Mydriatic (tropicamide and phenylephrine) — 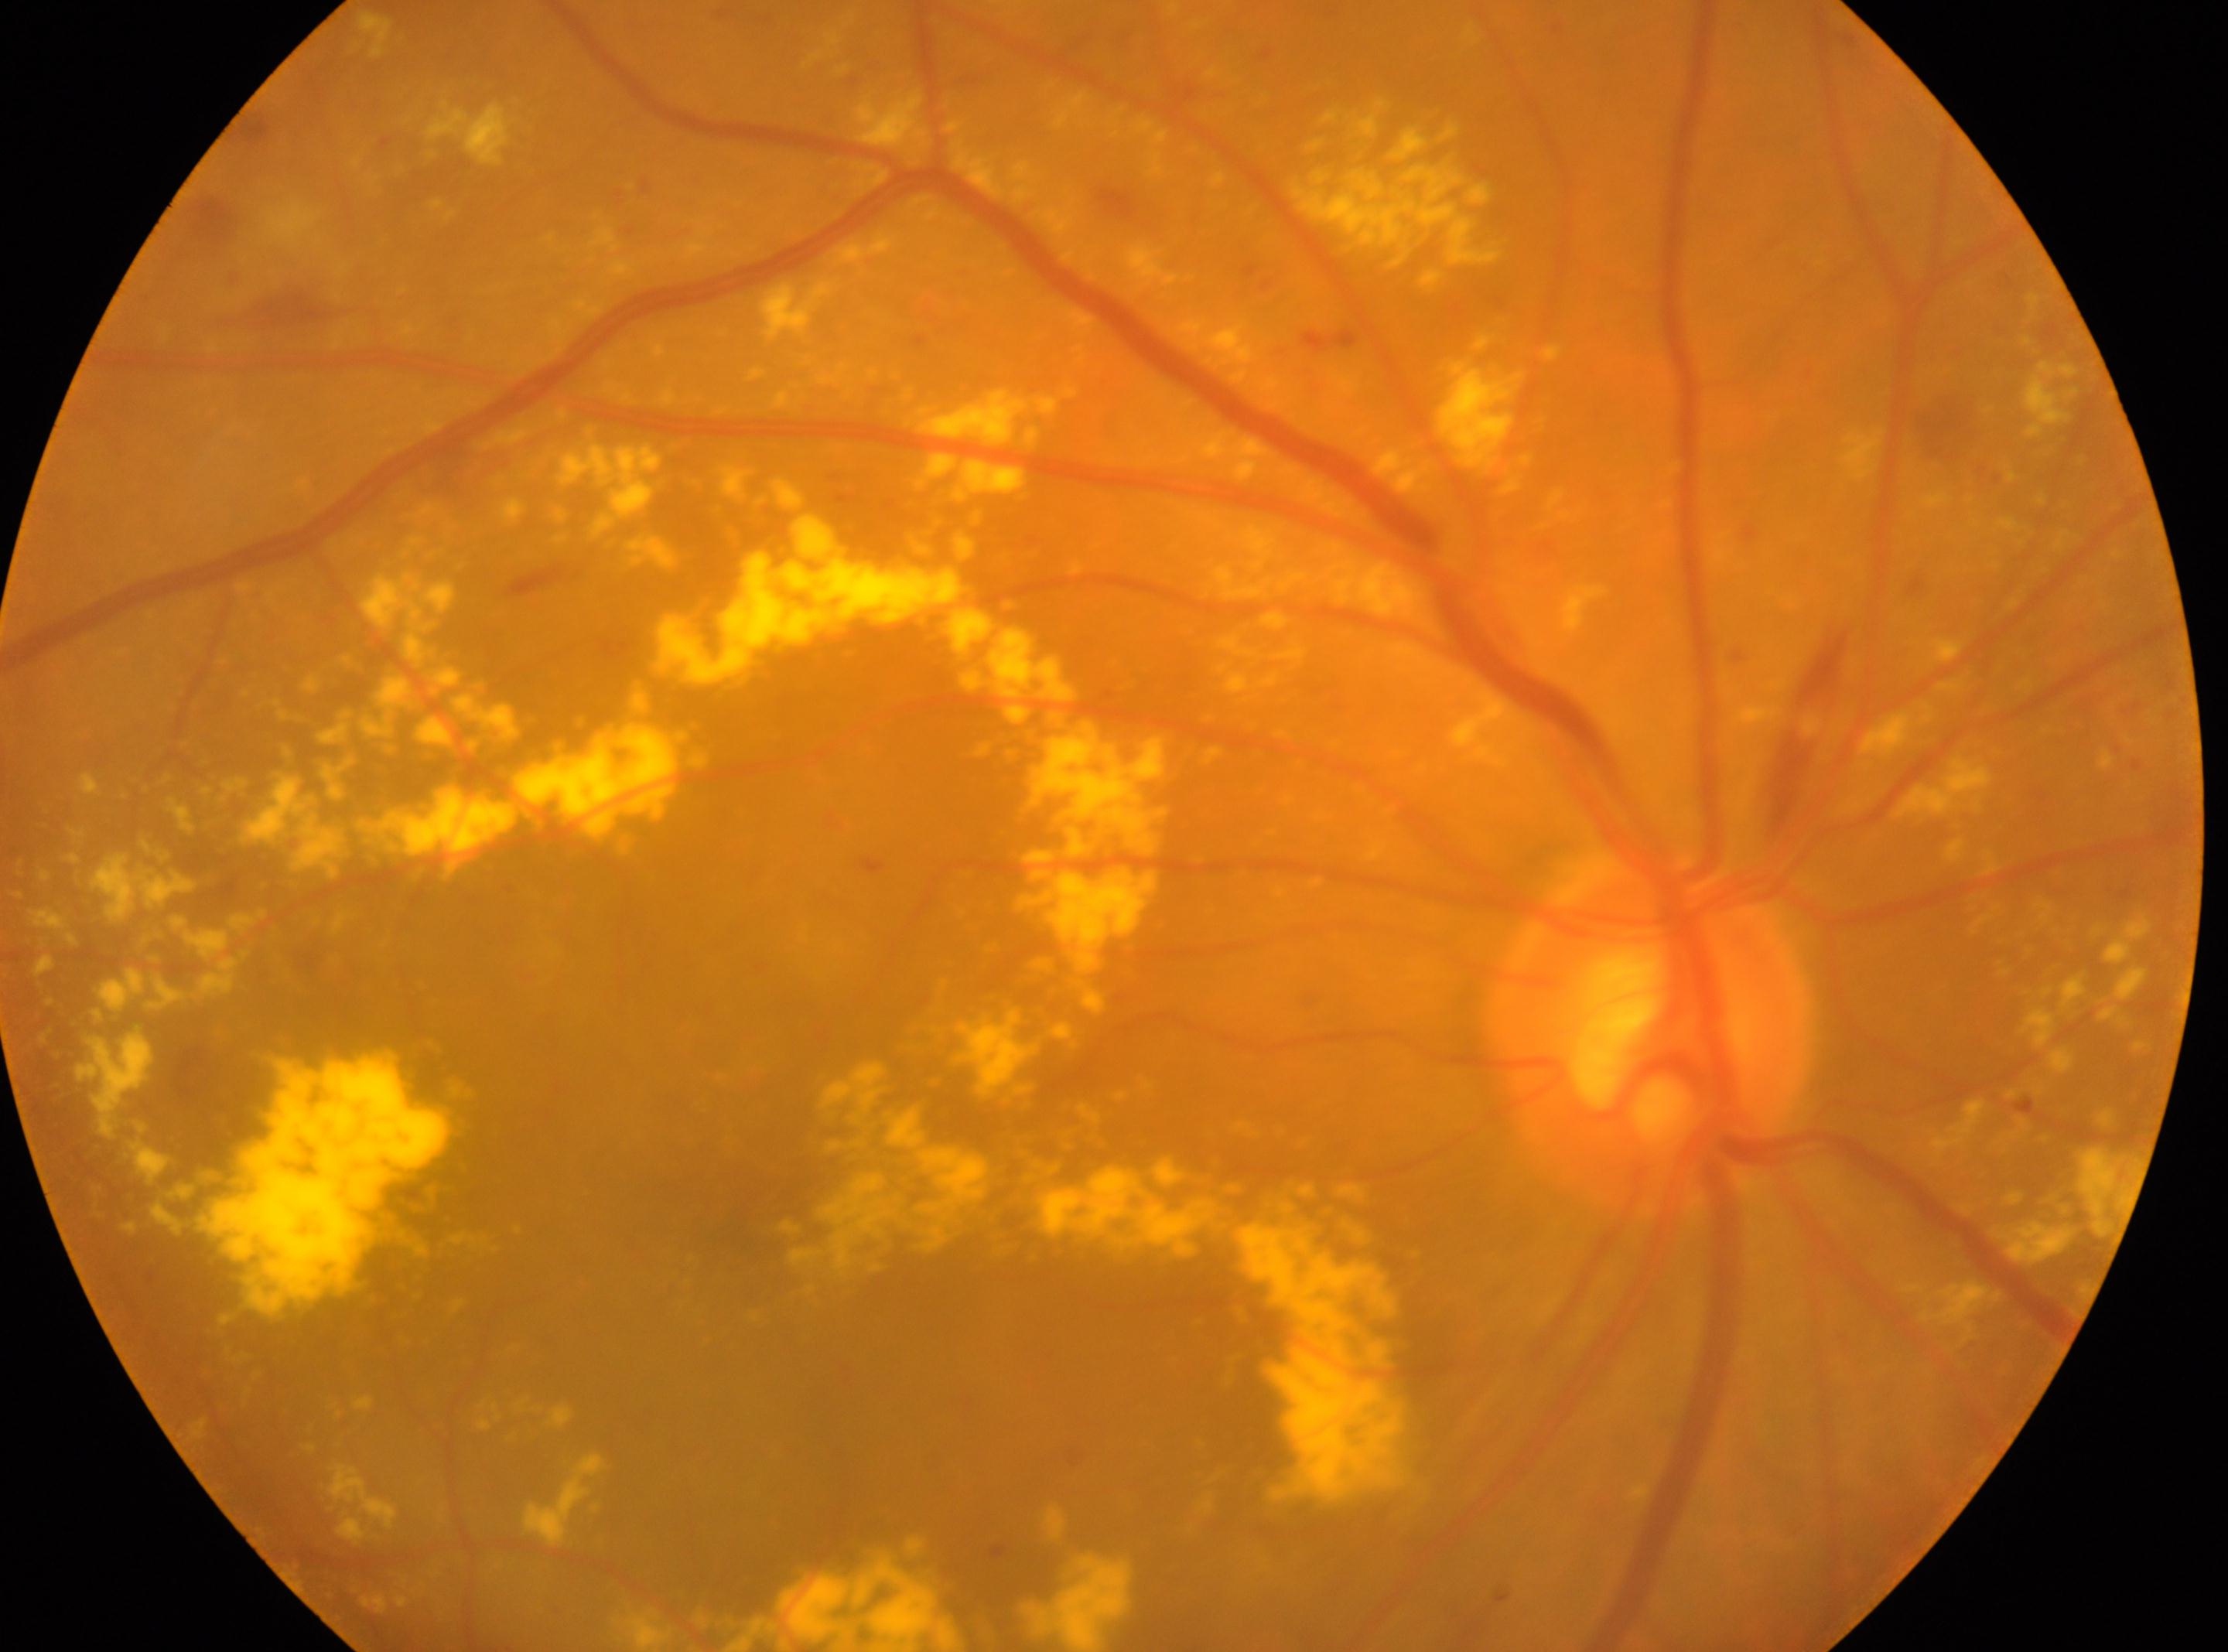 eye: the right eye
dr_category: non-proliferative diabetic retinopathy
fovea: 769, 1219
optic_disc: 1646, 1033
dr_grade: 2 (moderate NPDR) — more than just microaneurysms but less than severe NPDR